240 by 240 pixels · non-mydriatic acquisition: 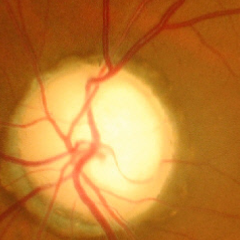 Optic disc photograph demonstrating advanced-stage glaucoma.